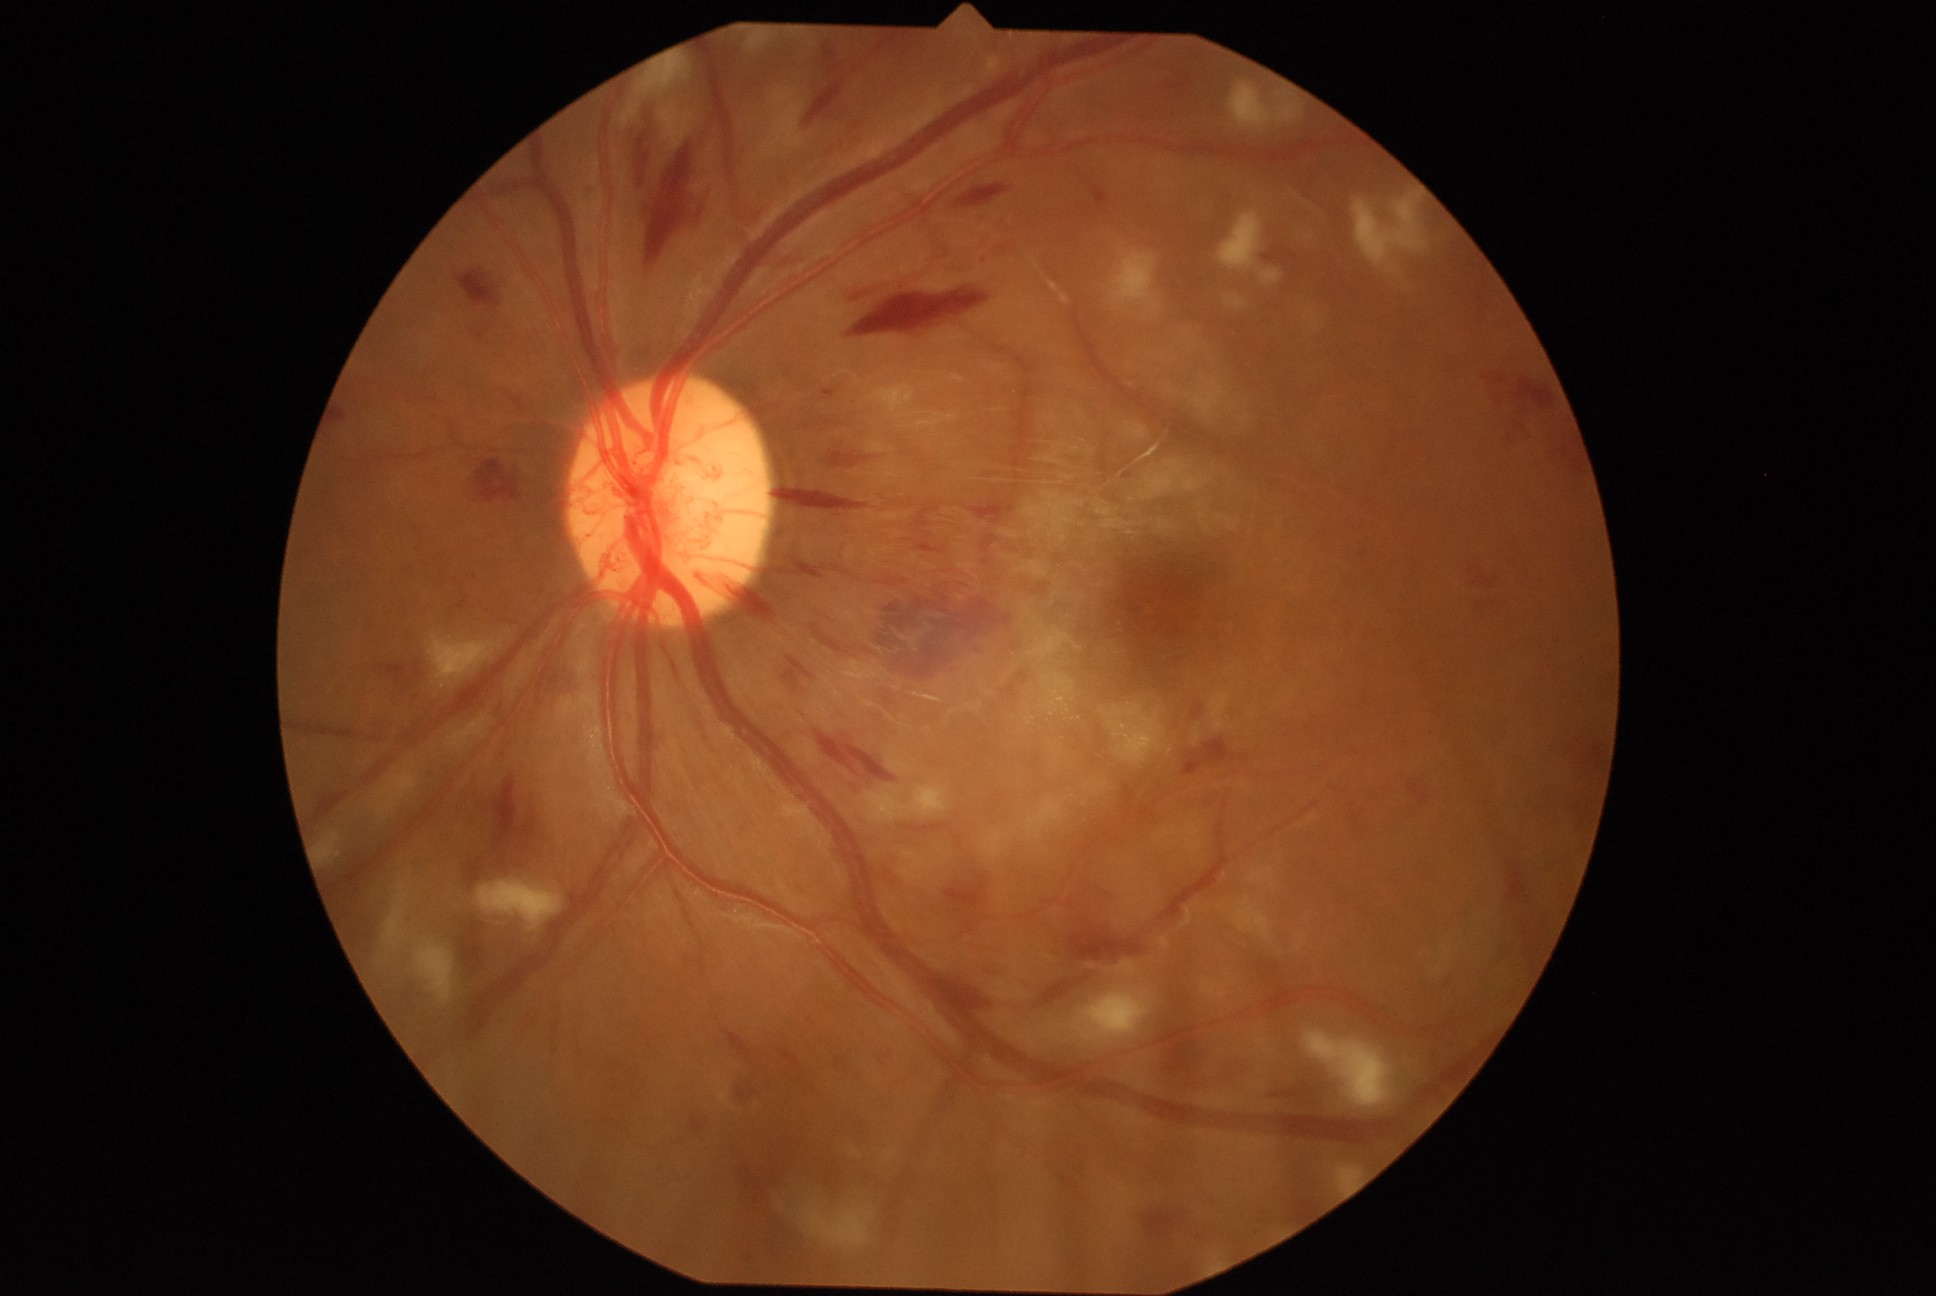
DR grade is 4 (PDR); proliferative diabetic retinopathy.
No EXs identified.
MAs identified at [457, 598, 468, 610].
MAs (small, approximate centers) near 984/260.
HEs are present, including at [746, 1254, 754, 1262]; [842, 277, 903, 304]; [494, 775, 539, 864]; [1507, 861, 1527, 904]; [632, 111, 661, 186]; [477, 331, 485, 343]; [970, 501, 1007, 523]; [754, 1197, 758, 1206]; [1474, 576, 1494, 590]; [461, 920, 485, 970]; [983, 535, 996, 552]; [734, 1084, 758, 1101]; [1093, 186, 1108, 209]; [836, 1058, 847, 1070]; [878, 598, 1012, 682]; [465, 858, 483, 888]; [1162, 1039, 1202, 1074]; [1263, 247, 1298, 263].
SEs are present, including at [621, 102, 640, 129]; [477, 882, 564, 932]; [800, 1209, 871, 1247]; [314, 833, 341, 866]; [762, 88, 803, 158]; [1074, 990, 1150, 1041]; [637, 53, 686, 96]; [876, 385, 915, 413]; [416, 945, 456, 1005]; [1226, 296, 1246, 310]; [1028, 627, 1084, 660]; [1042, 674, 1075, 712]; [749, 33, 767, 50]; [1304, 1032, 1392, 1108].